Davis DR grading
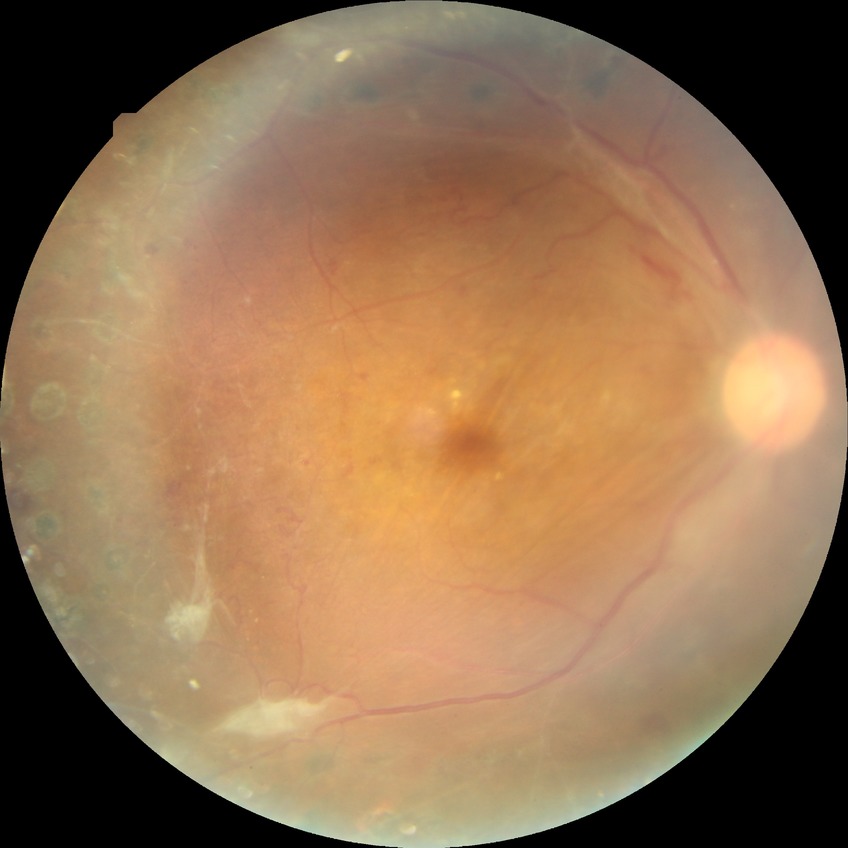

diabetic retinopathy grade=proliferative diabetic retinopathy.